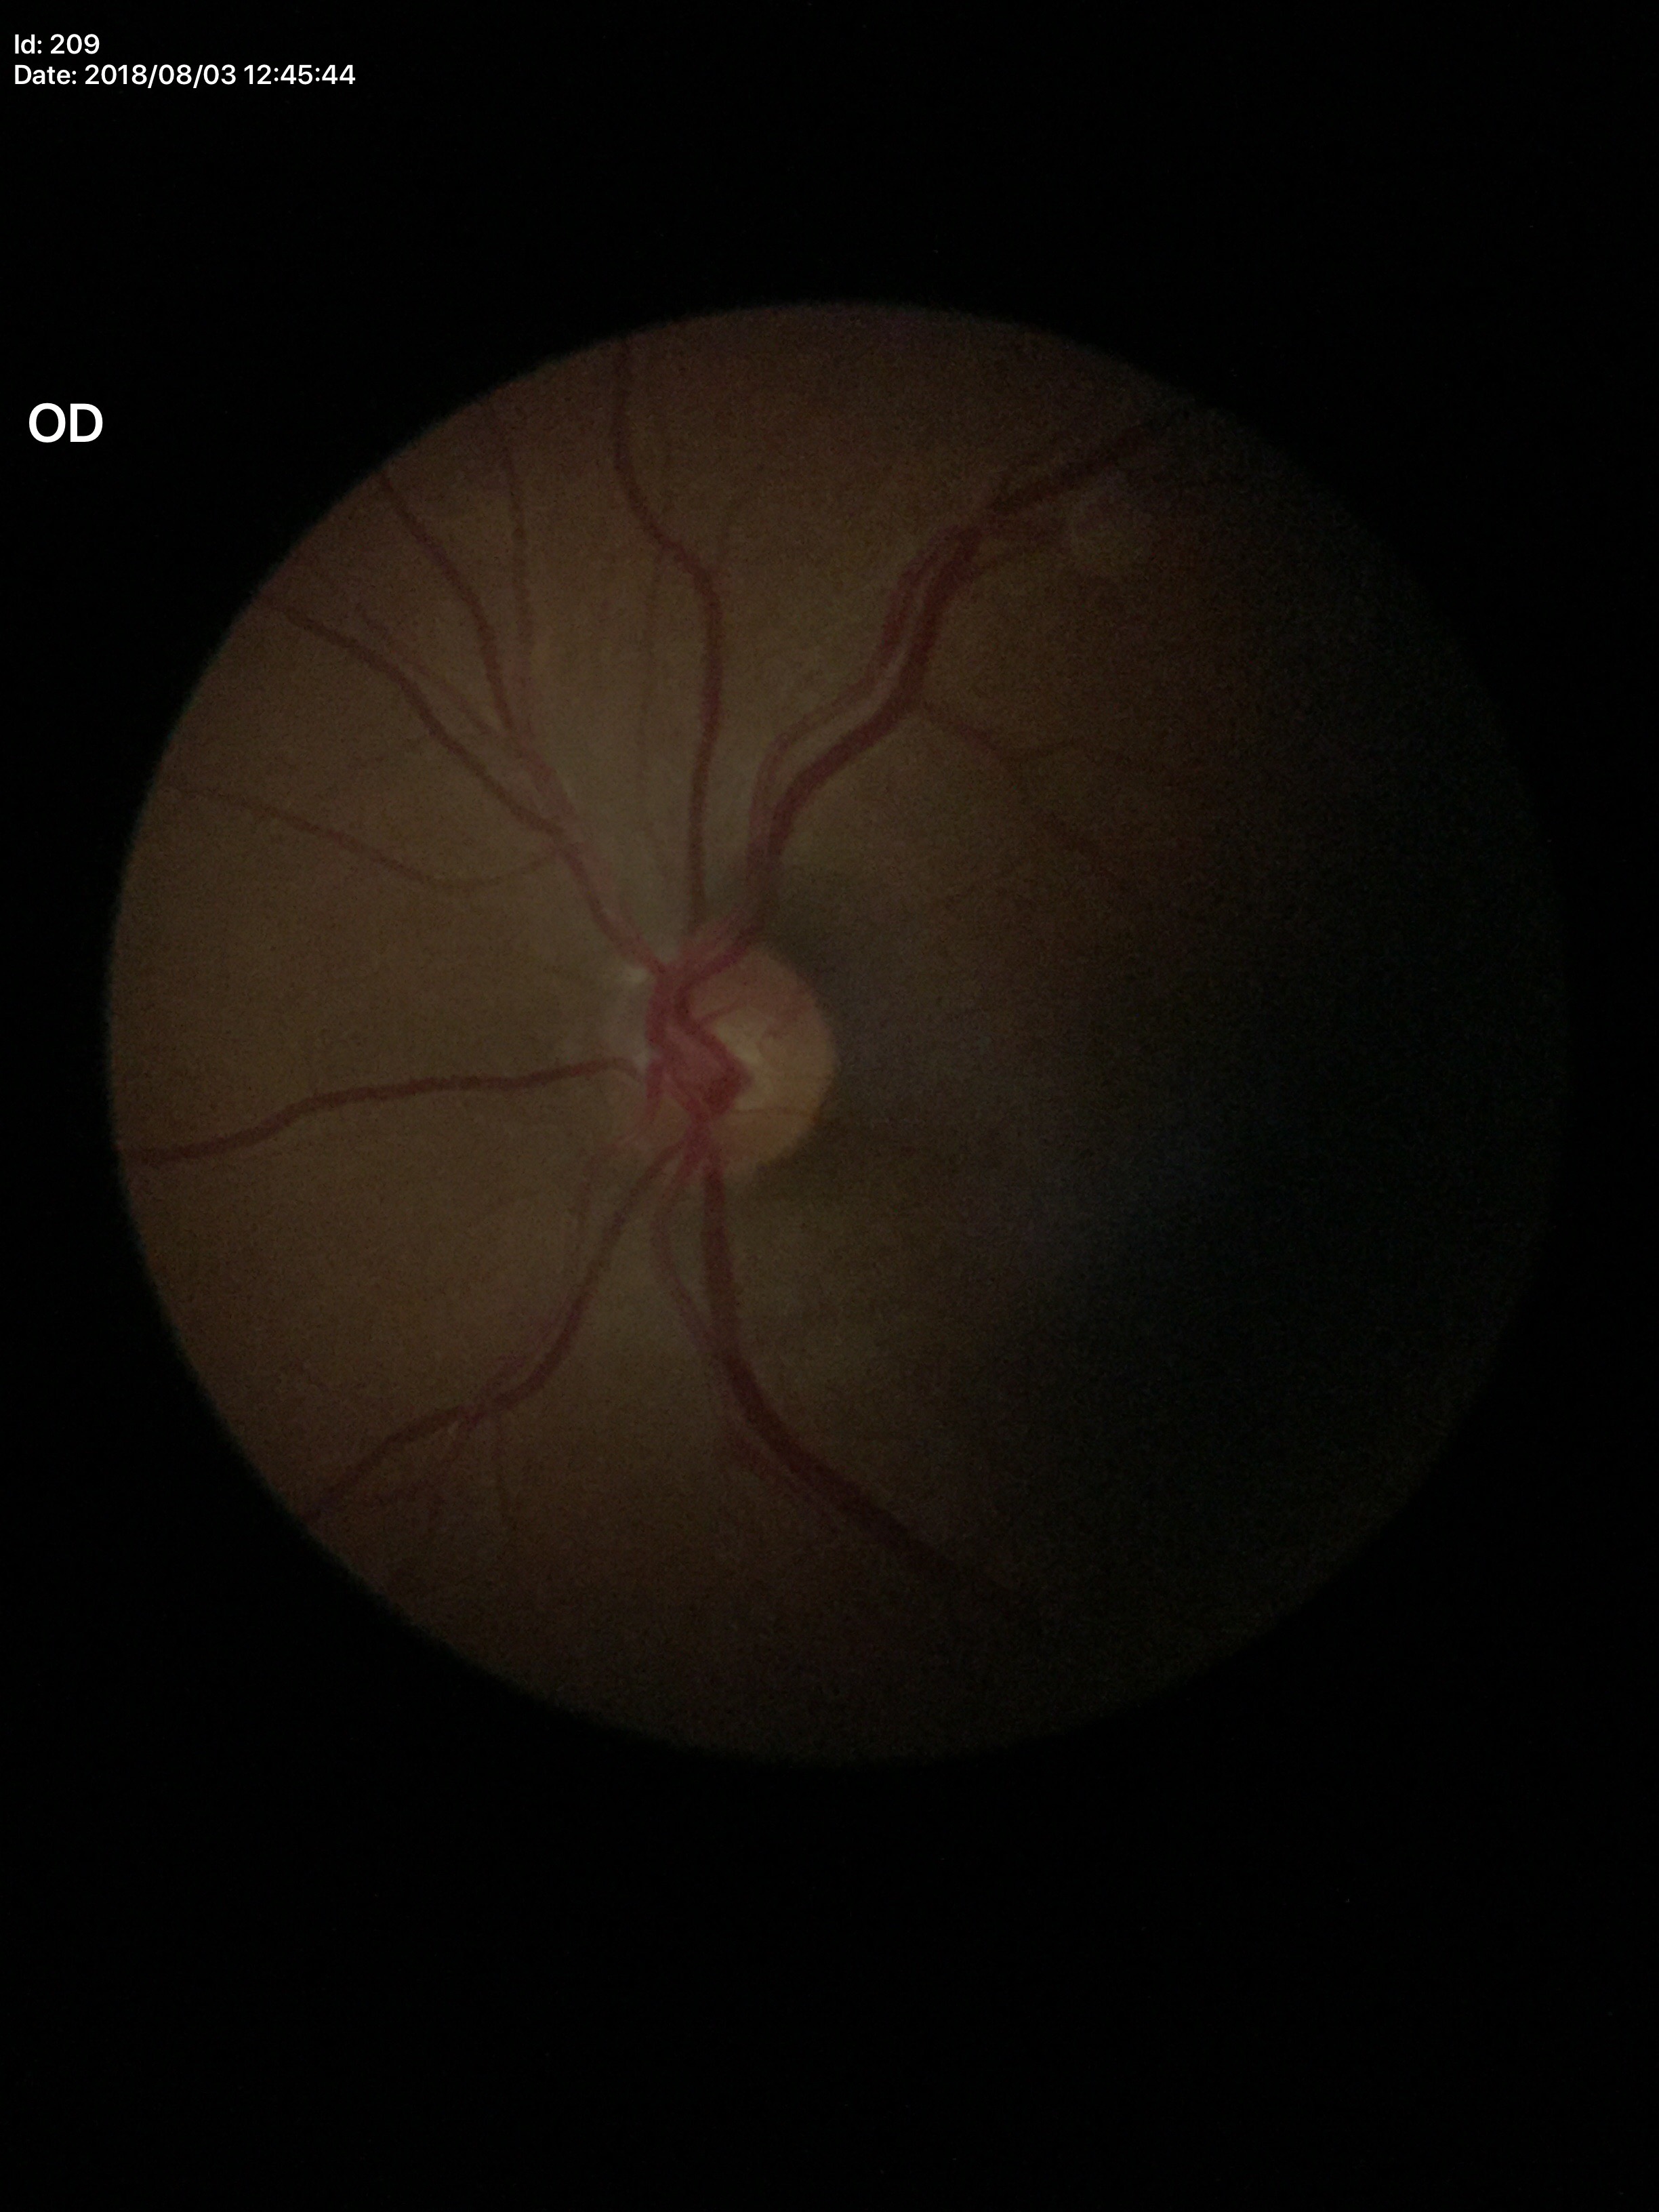 No signs of glaucoma.
Vertical CDR: 0.51.
Horizontal CDR is 0.53.